Wide-field fundus photograph from neonatal ROP screening: 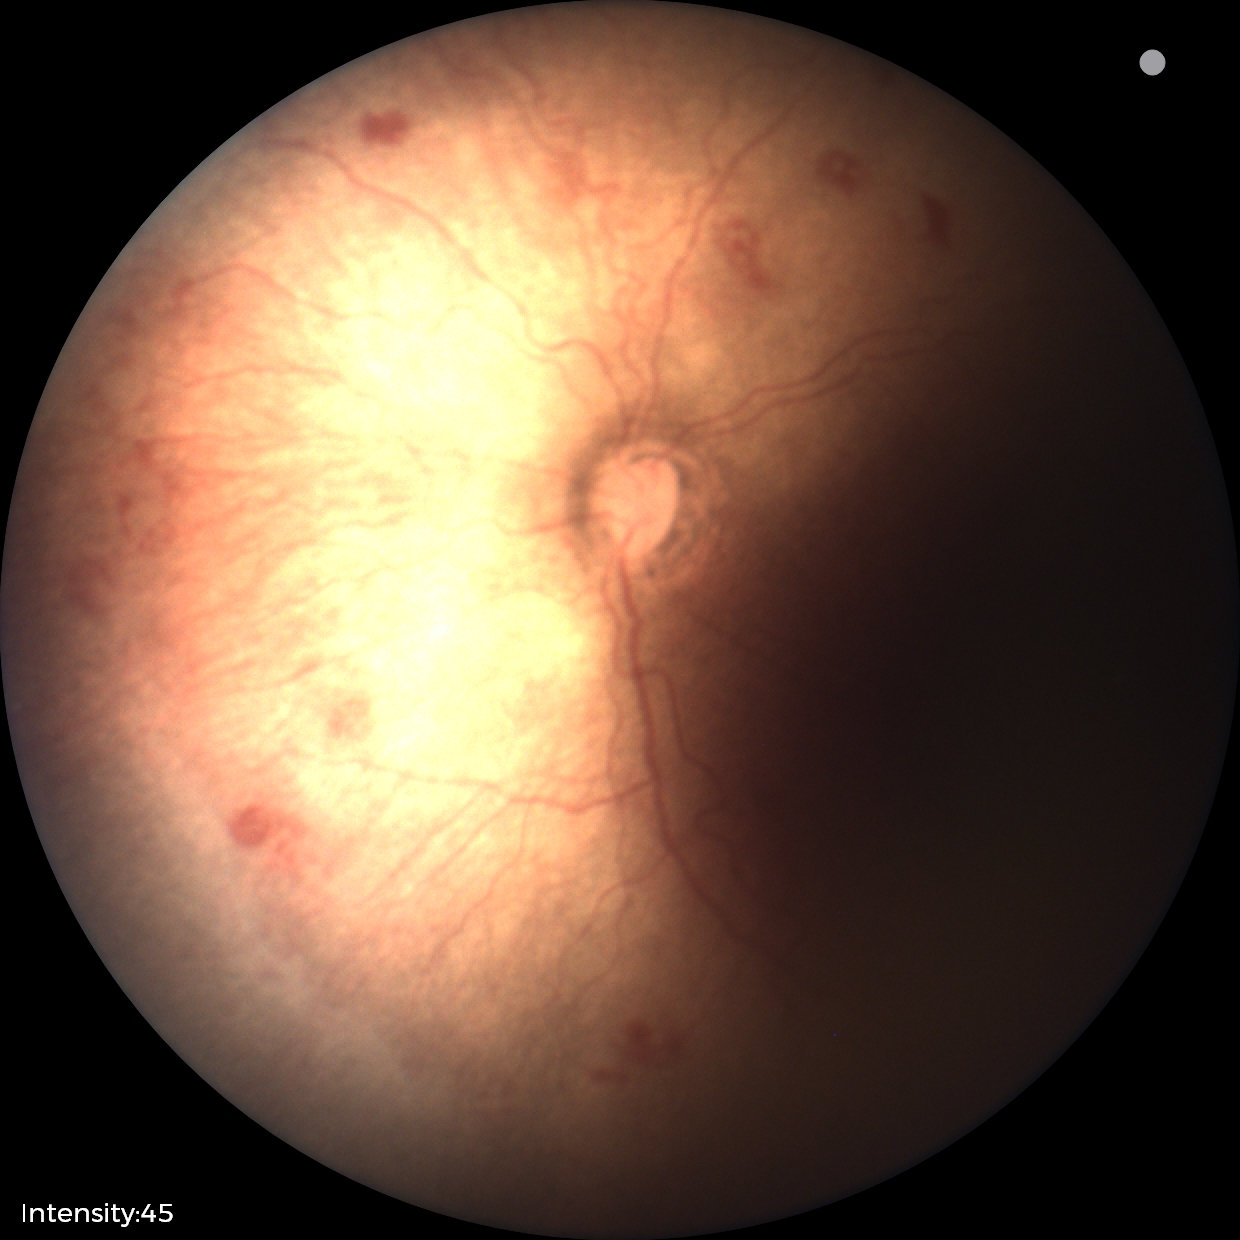 Assessment = retinopathy of prematurity (ROP) stage 1 — demarcation line between vascular and avascular retina
plus disease = absent